Camera: Phoenix ICON (100° FOV) · 1240 by 1240 pixels · wide-field fundus image from infant ROP screening — 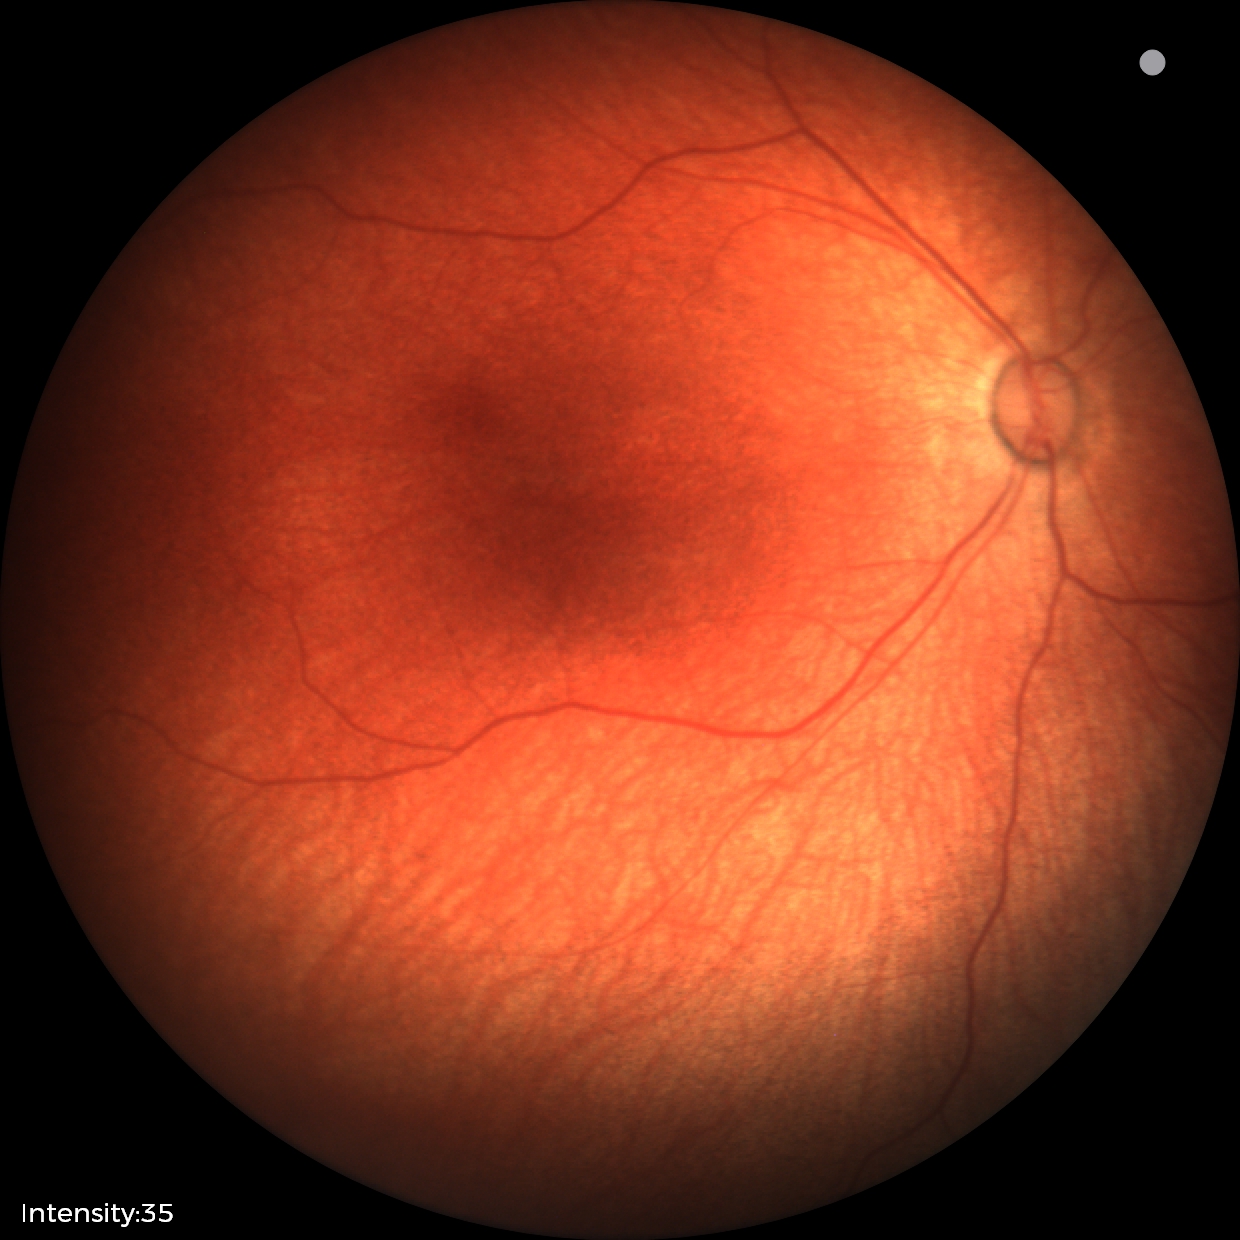 Screening examination diagnosed as physiological.